640x480 · pediatric retinal photograph (wide-field): 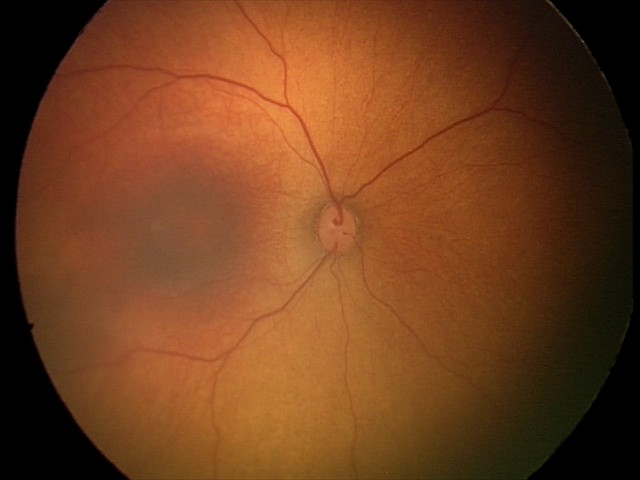
Impression: no abnormal retinal findings.